Modified Davis classification, color fundus image, 848x848, 45-degree field of view, without pupil dilation
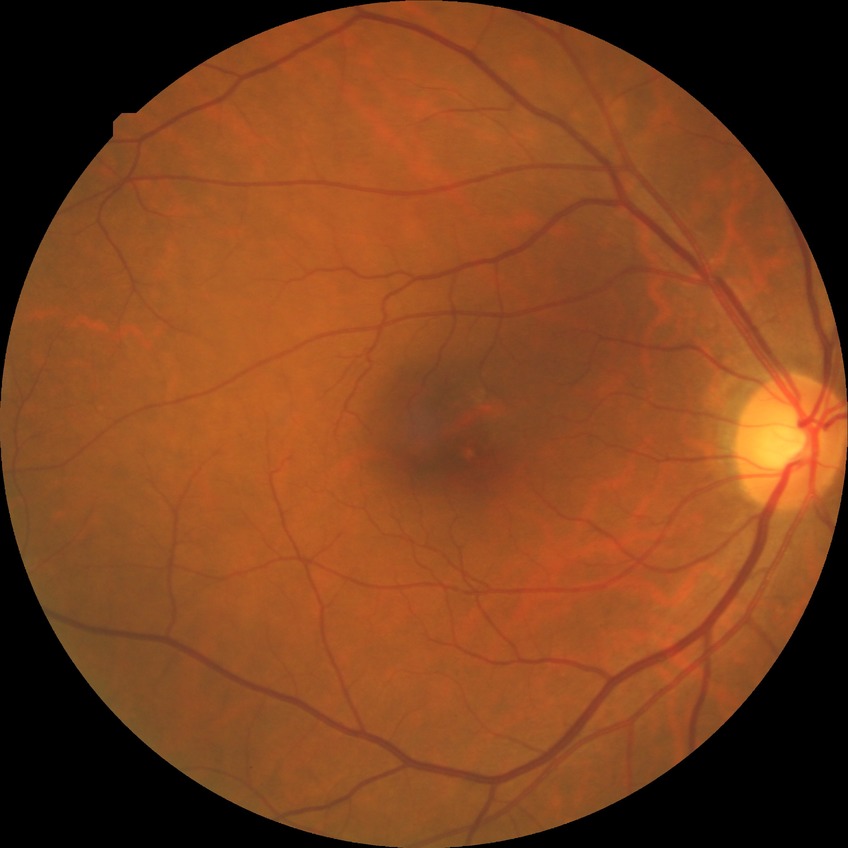

Davis DR grade: NDR.